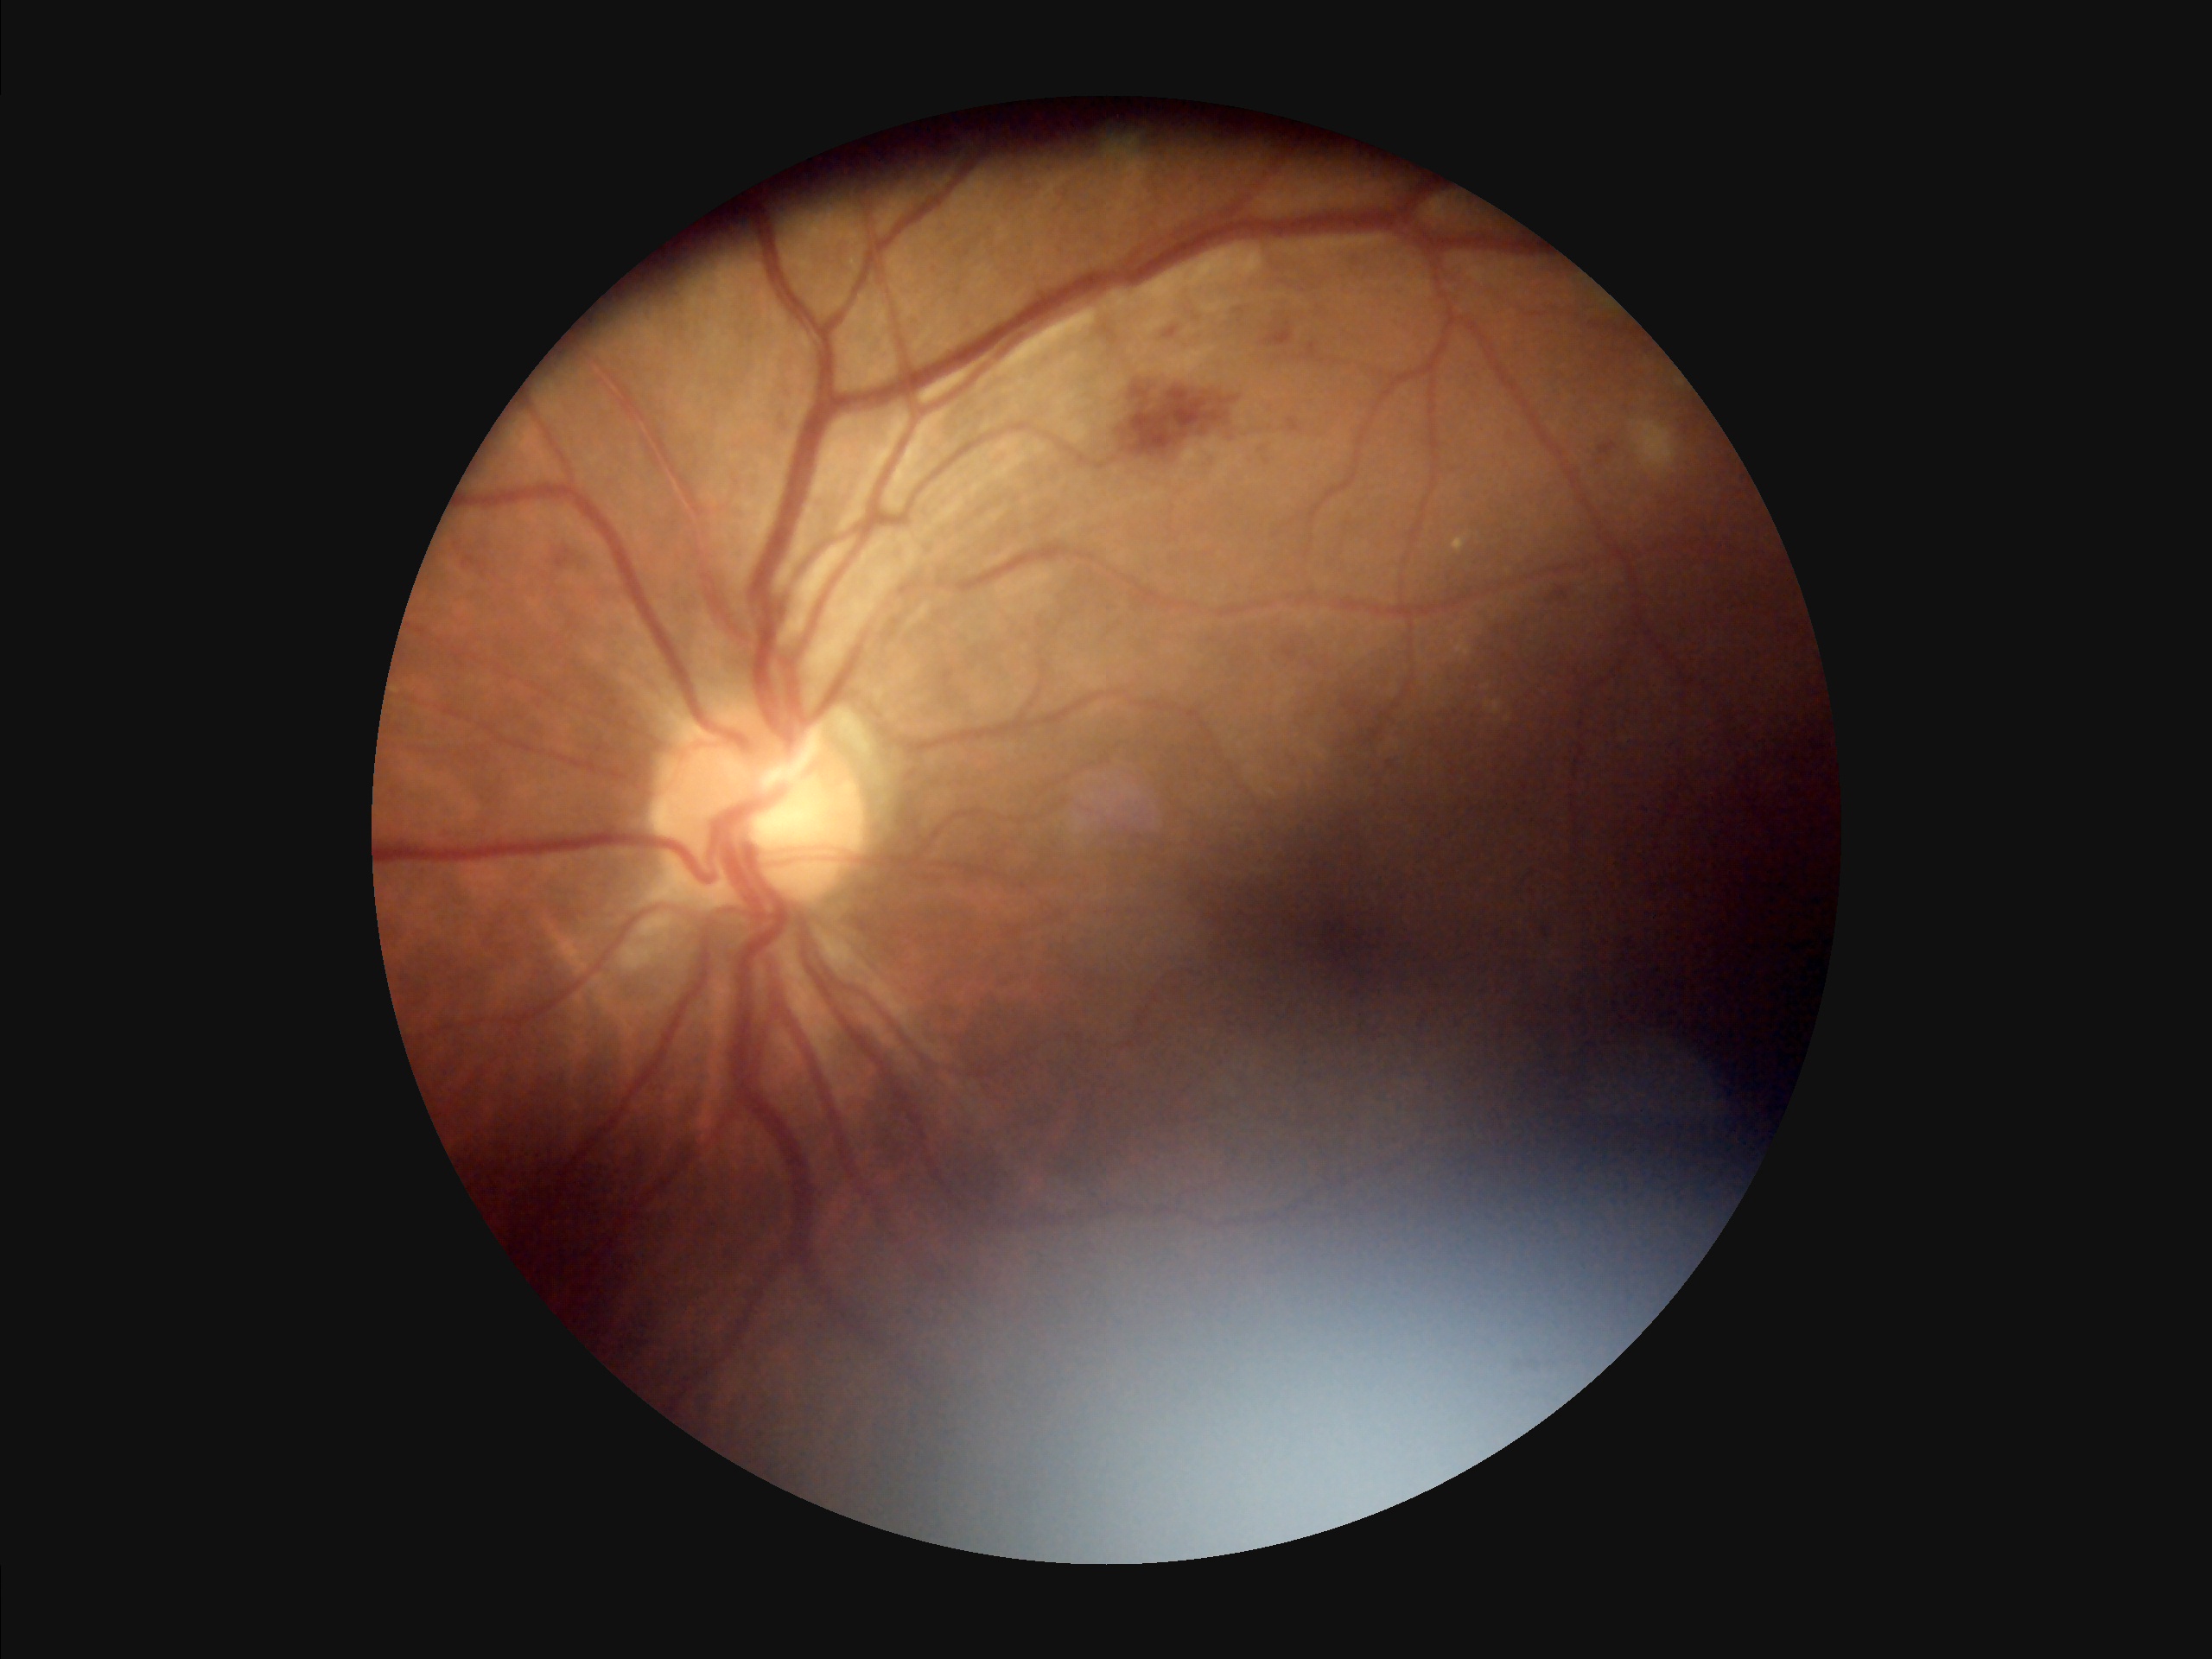
contrast: vessels and details readily distinguishable
overall_quality: poor, ungradable
clarity: noticeable blur in the optic disc, vessels, or background
illumination: inadequate, with uneven exposure or color distortion